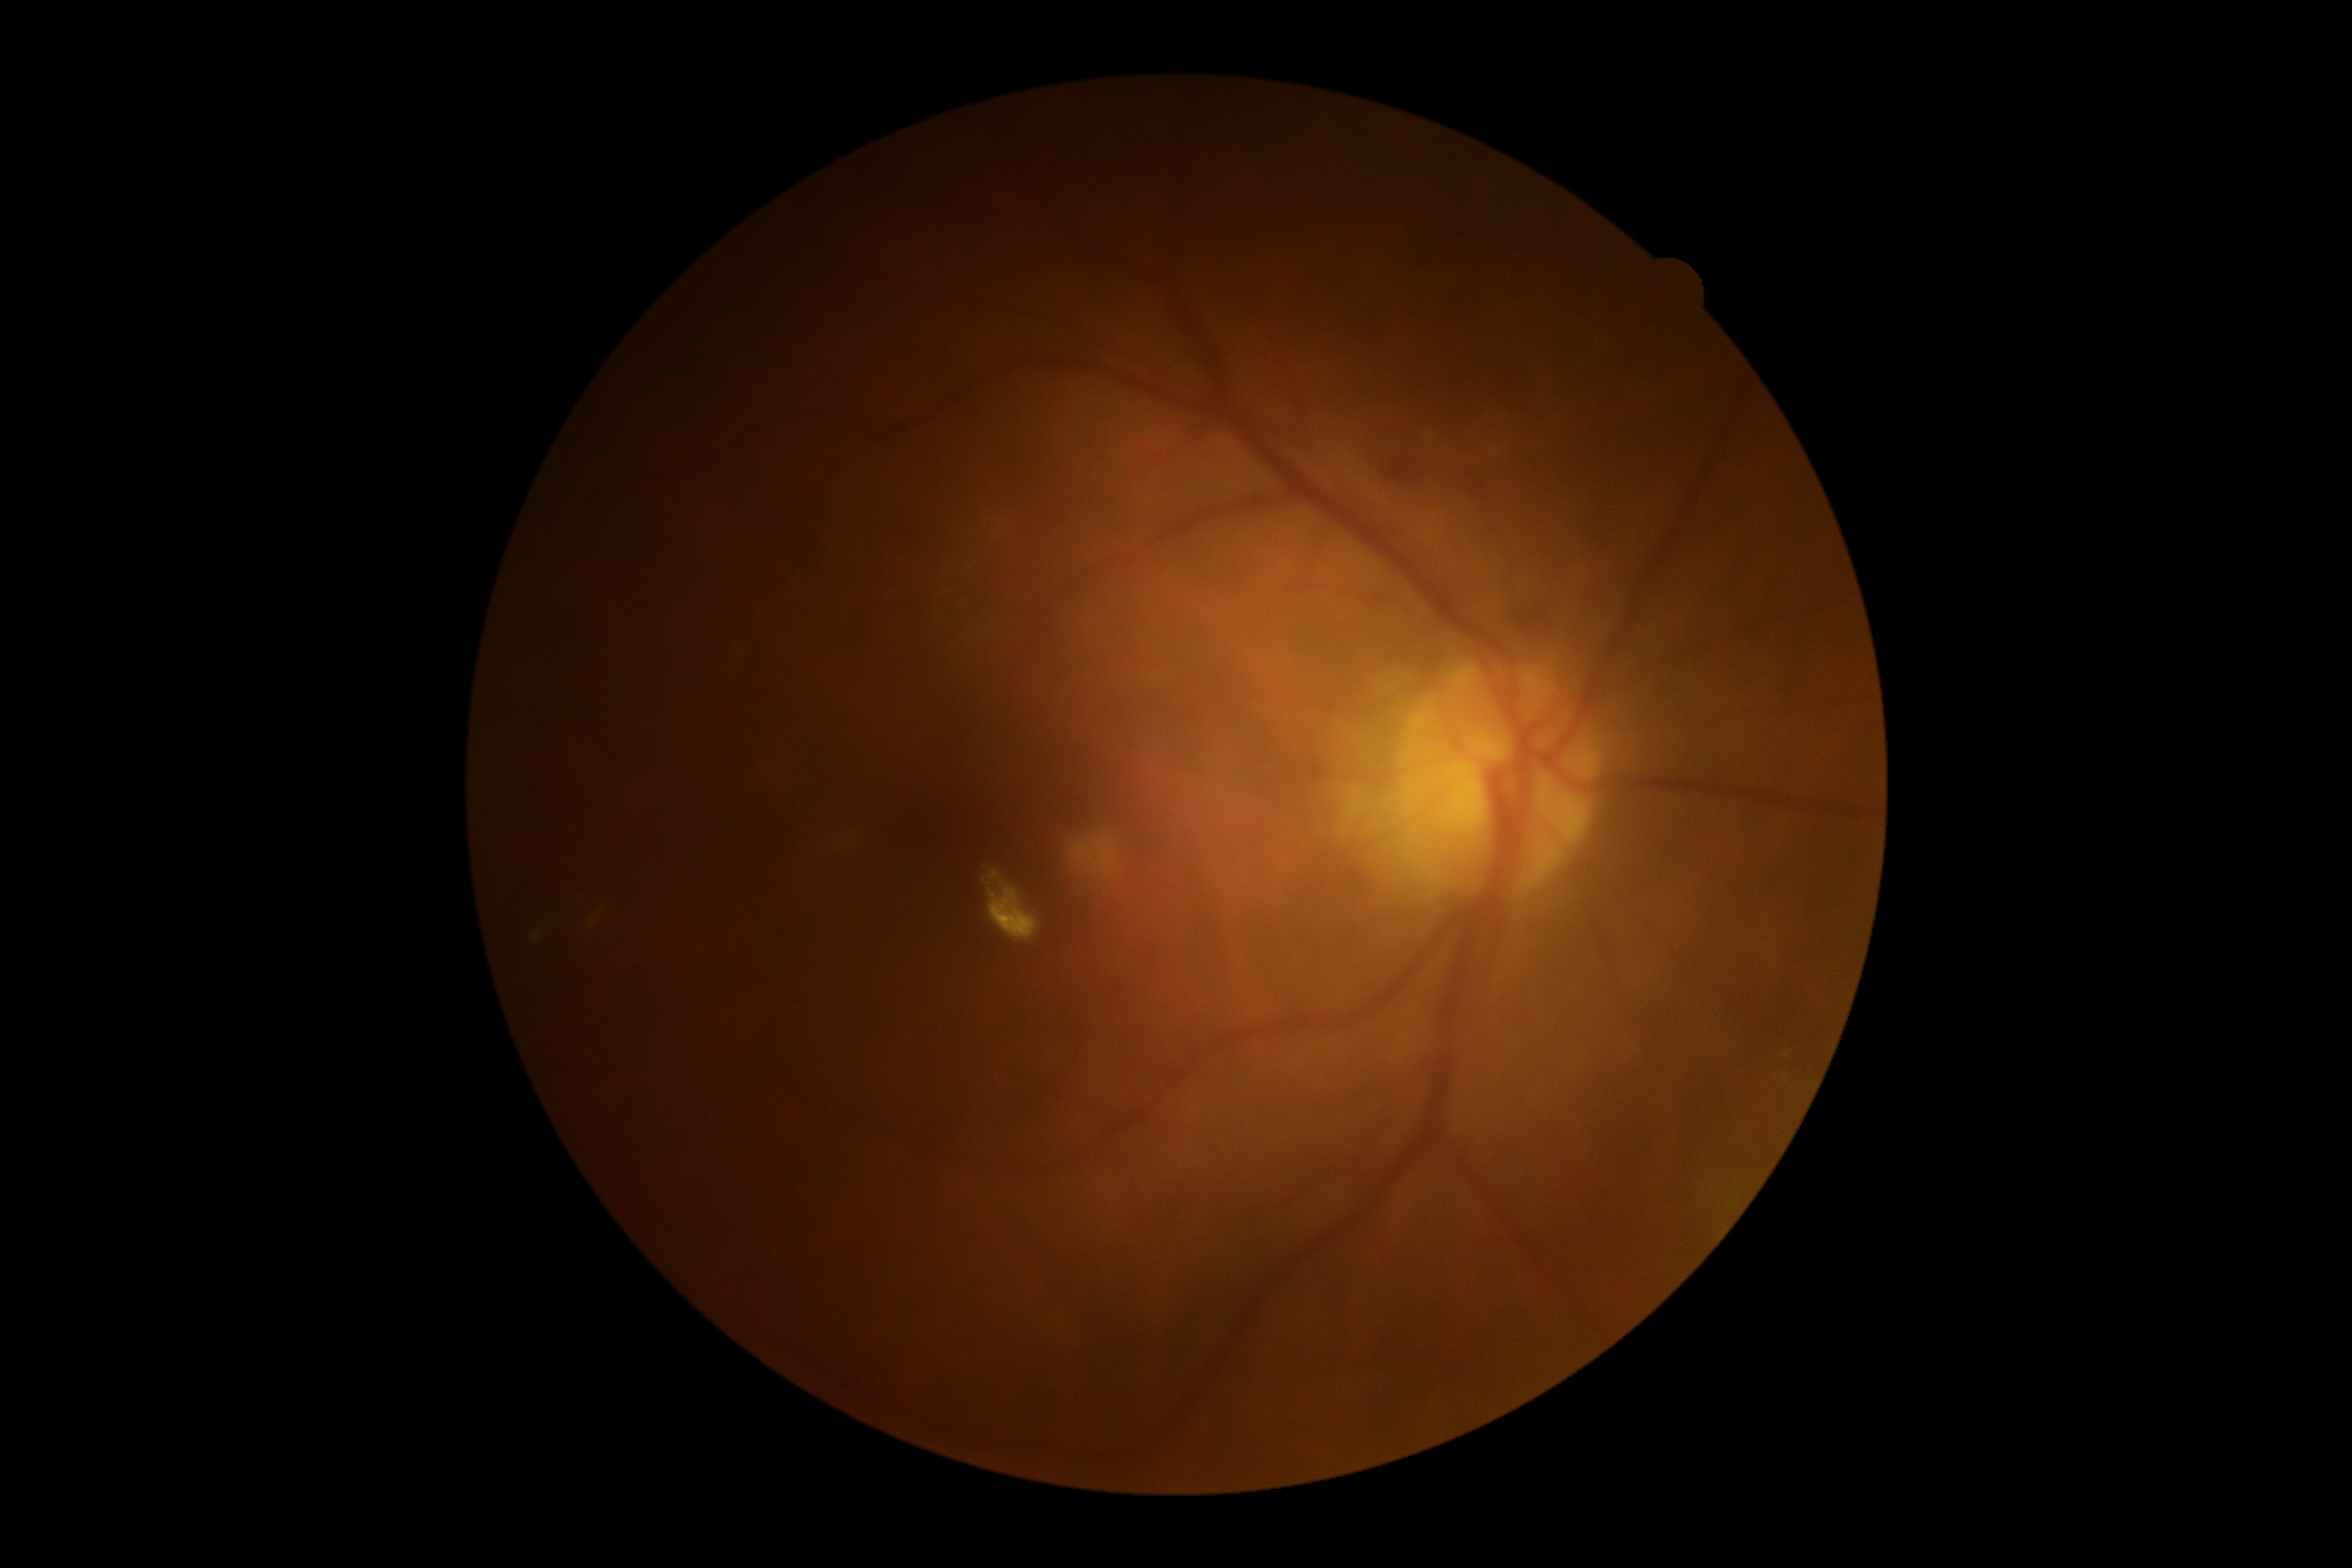
Diabetic retinopathy (DR) is grade 2 (moderate NPDR).